Fundus photo — 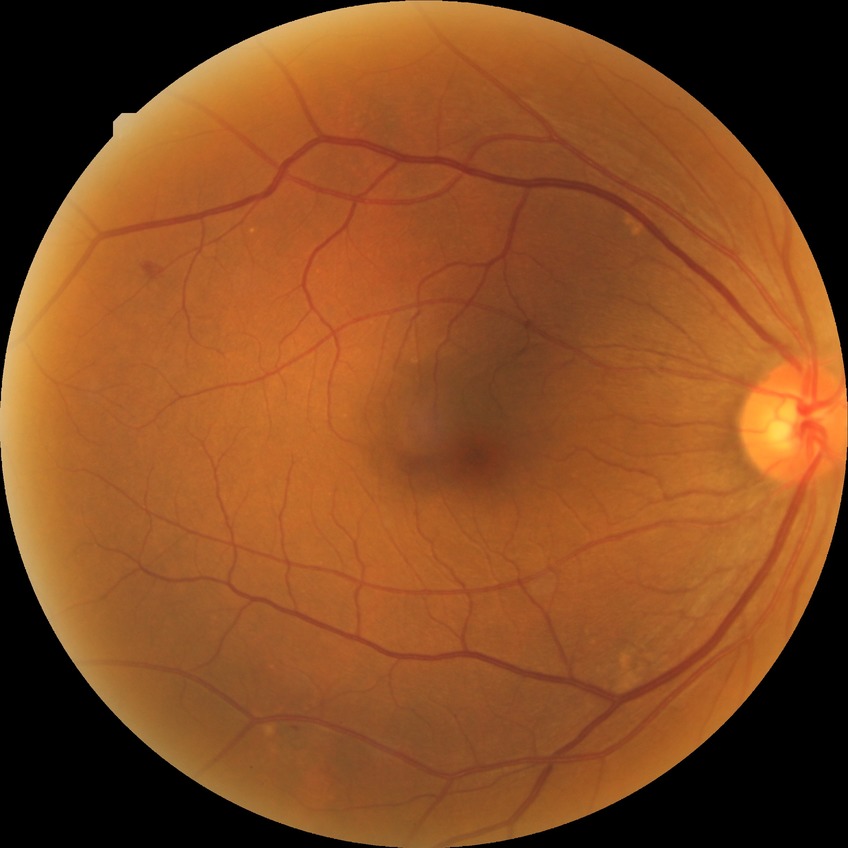

Diabetic retinopathy (DR) is NDR (no diabetic retinopathy).